Wide-field contact fundus photograph of an infant; 640 x 480 pixels — 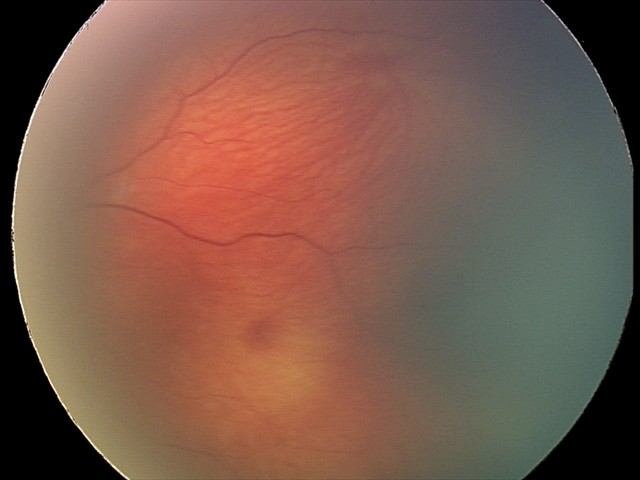
Series diagnosed as retinal hemorrhages.